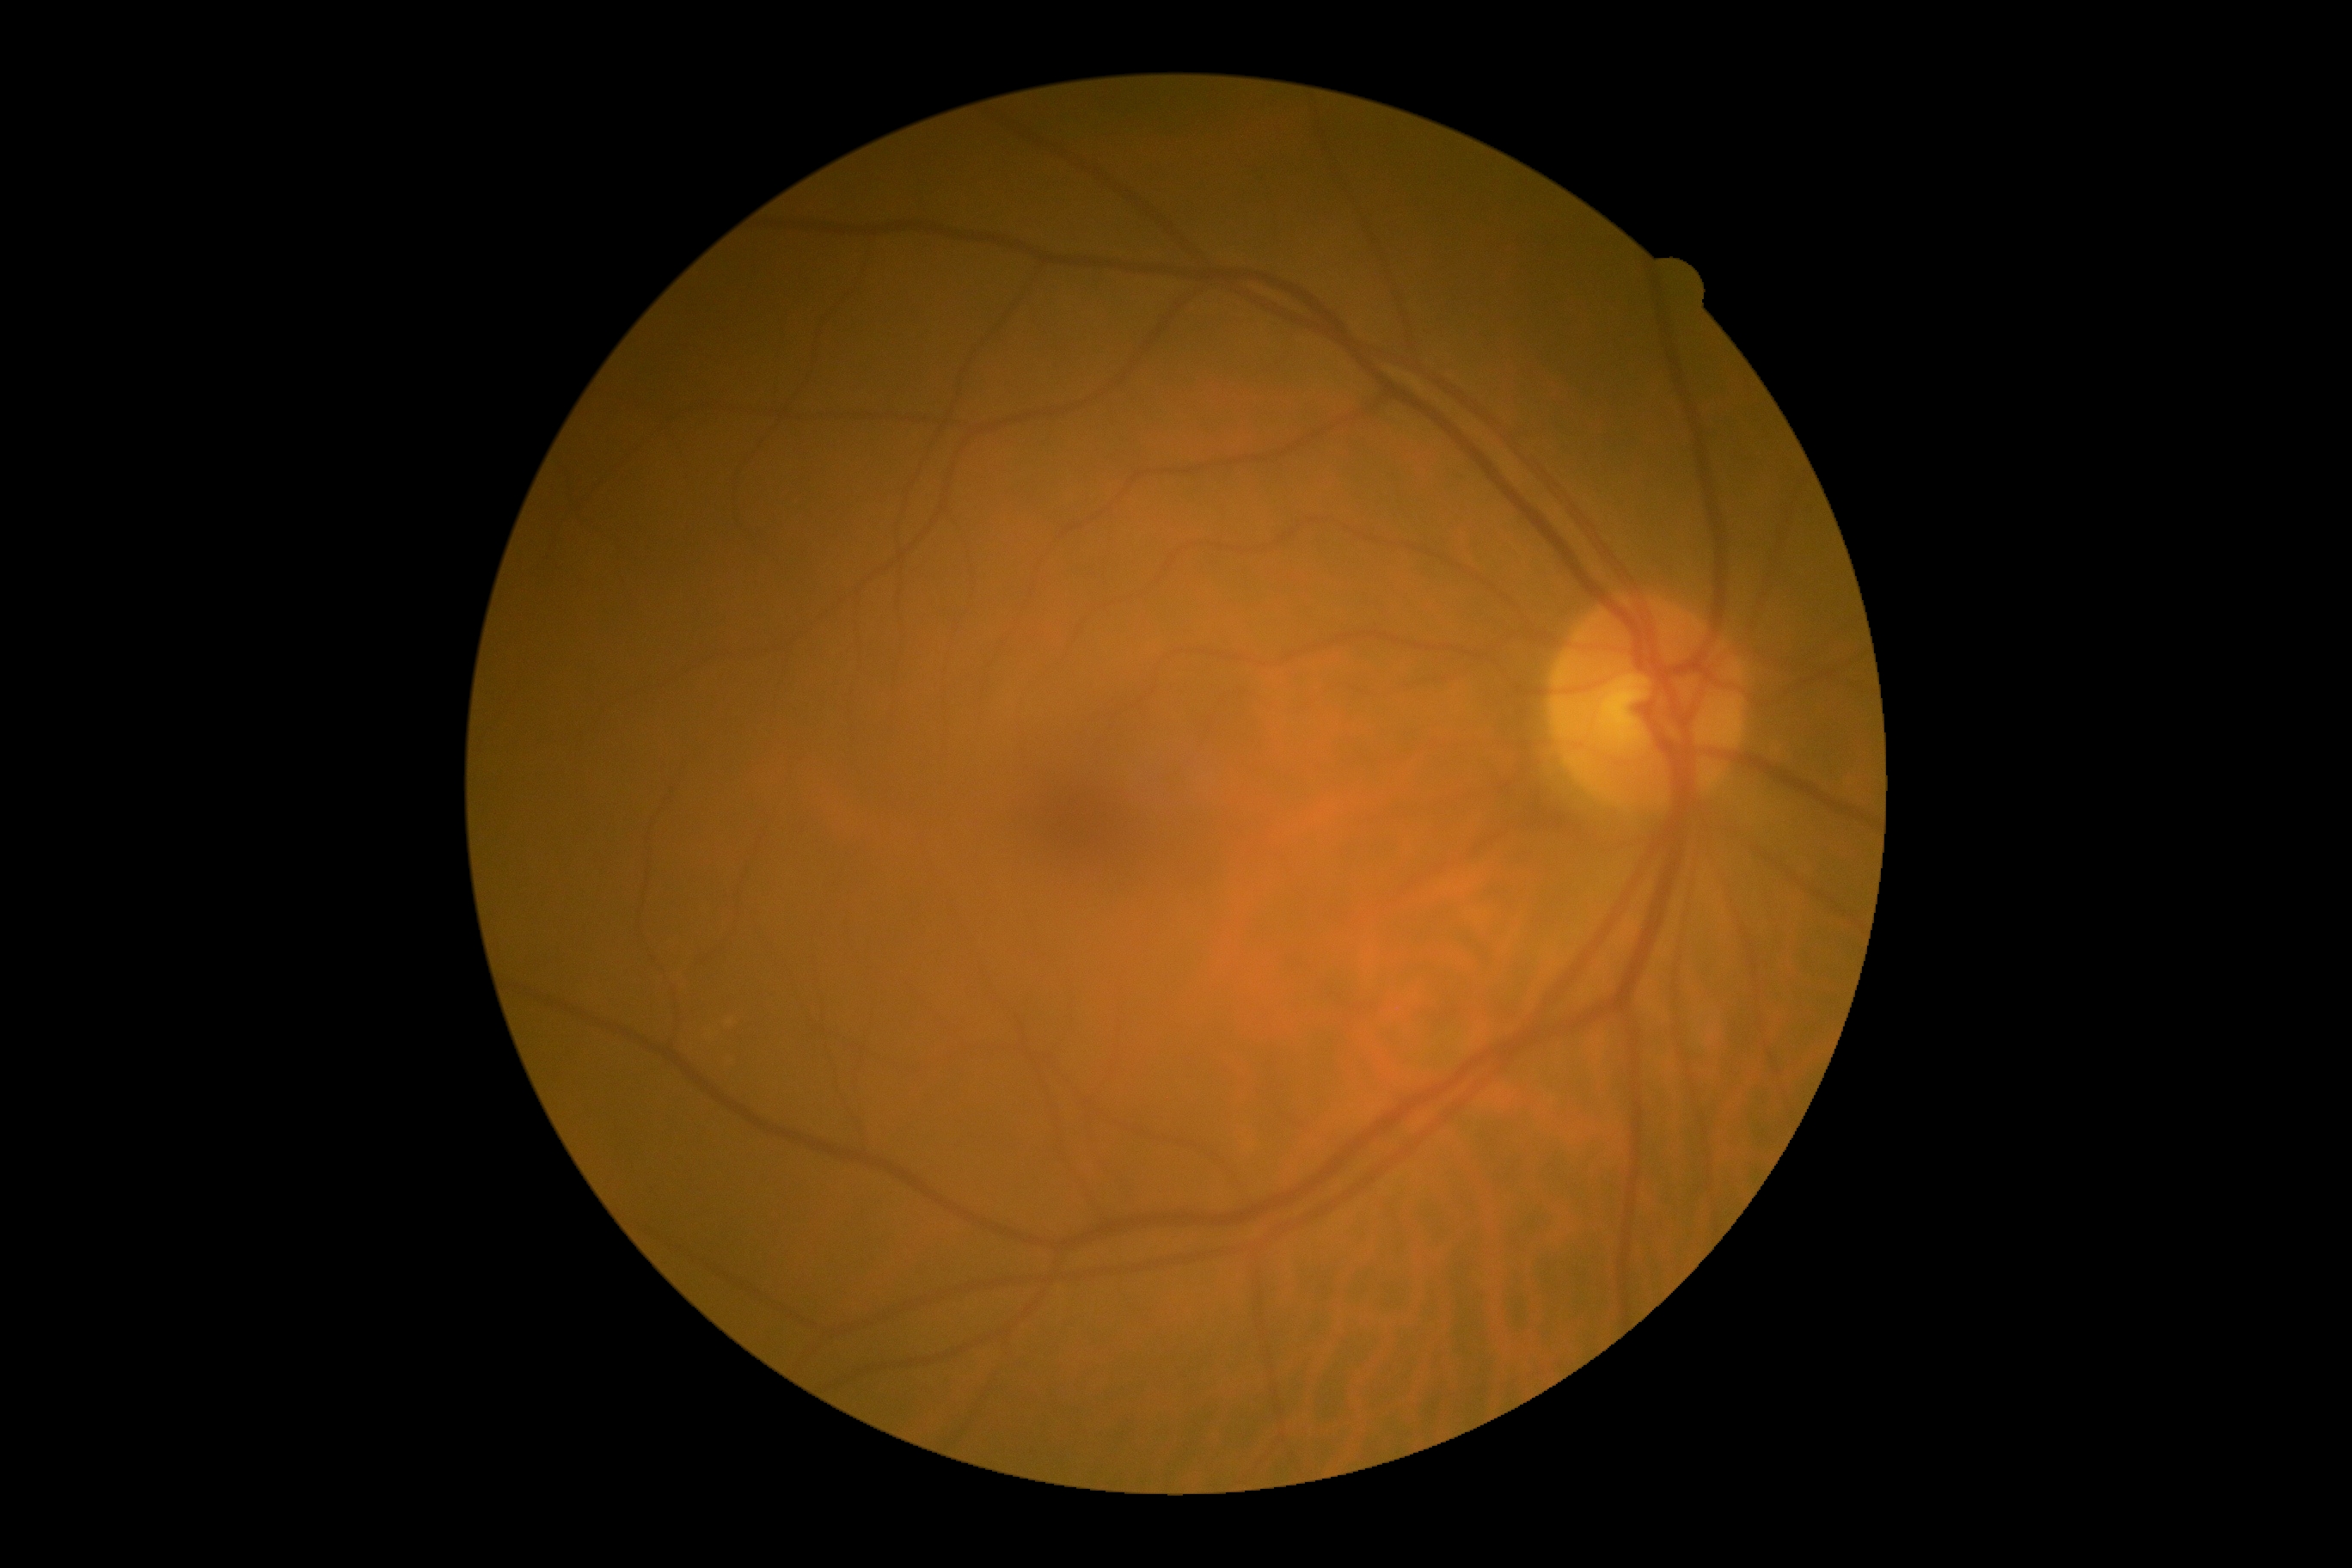   dr_grade: 0